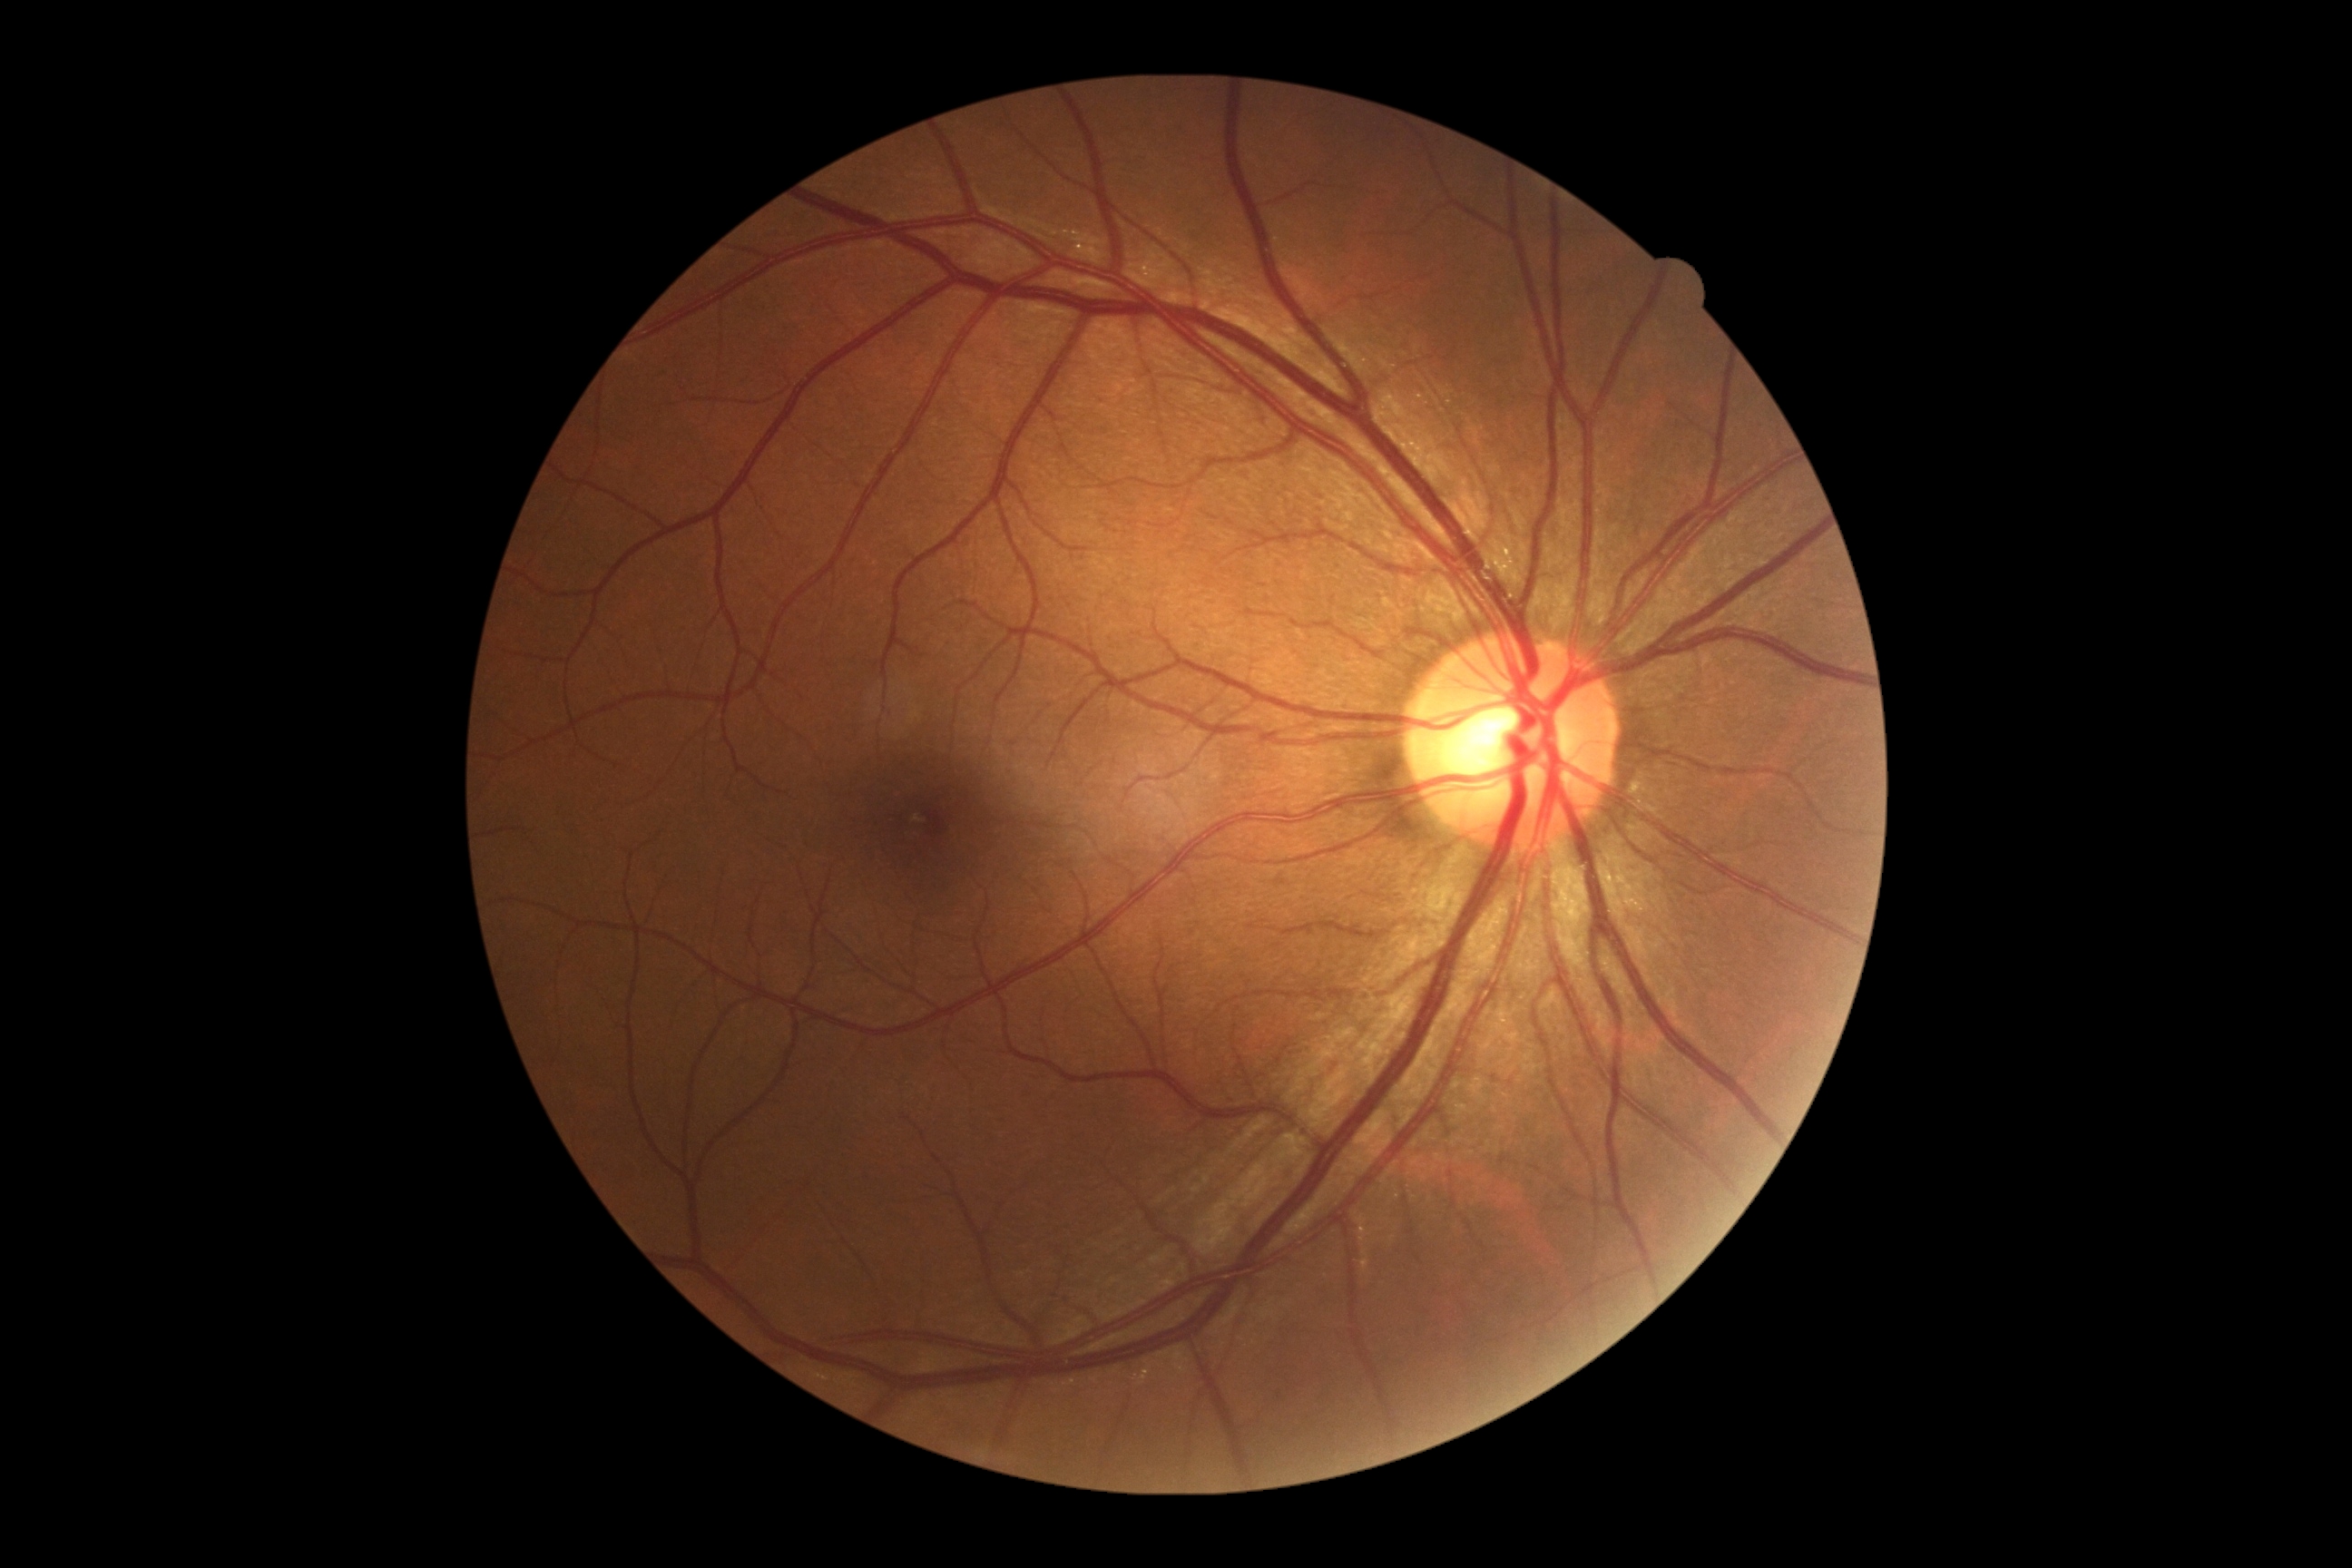

Diabetic retinopathy (DR): no apparent diabetic retinopathy (grade 0).
No DR findings.